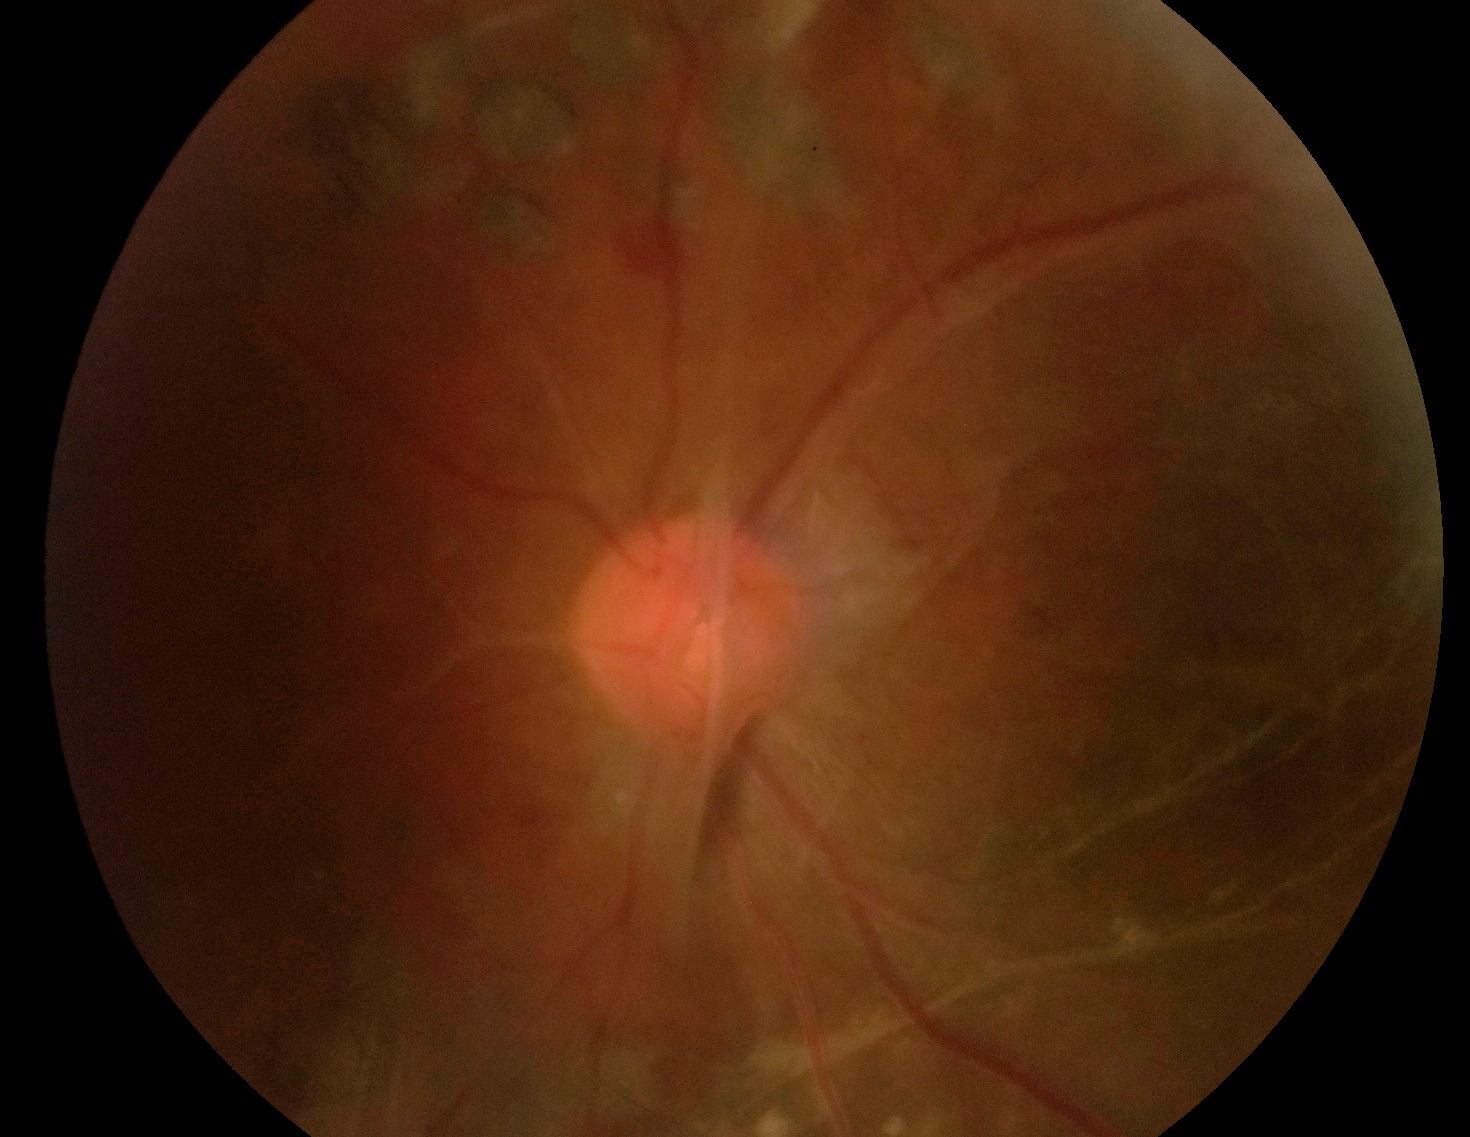

{"dr_grade": "proliferative diabetic retinopathy (grade 4)"}